Pediatric wide-field fundus photograph · 1240x1240px
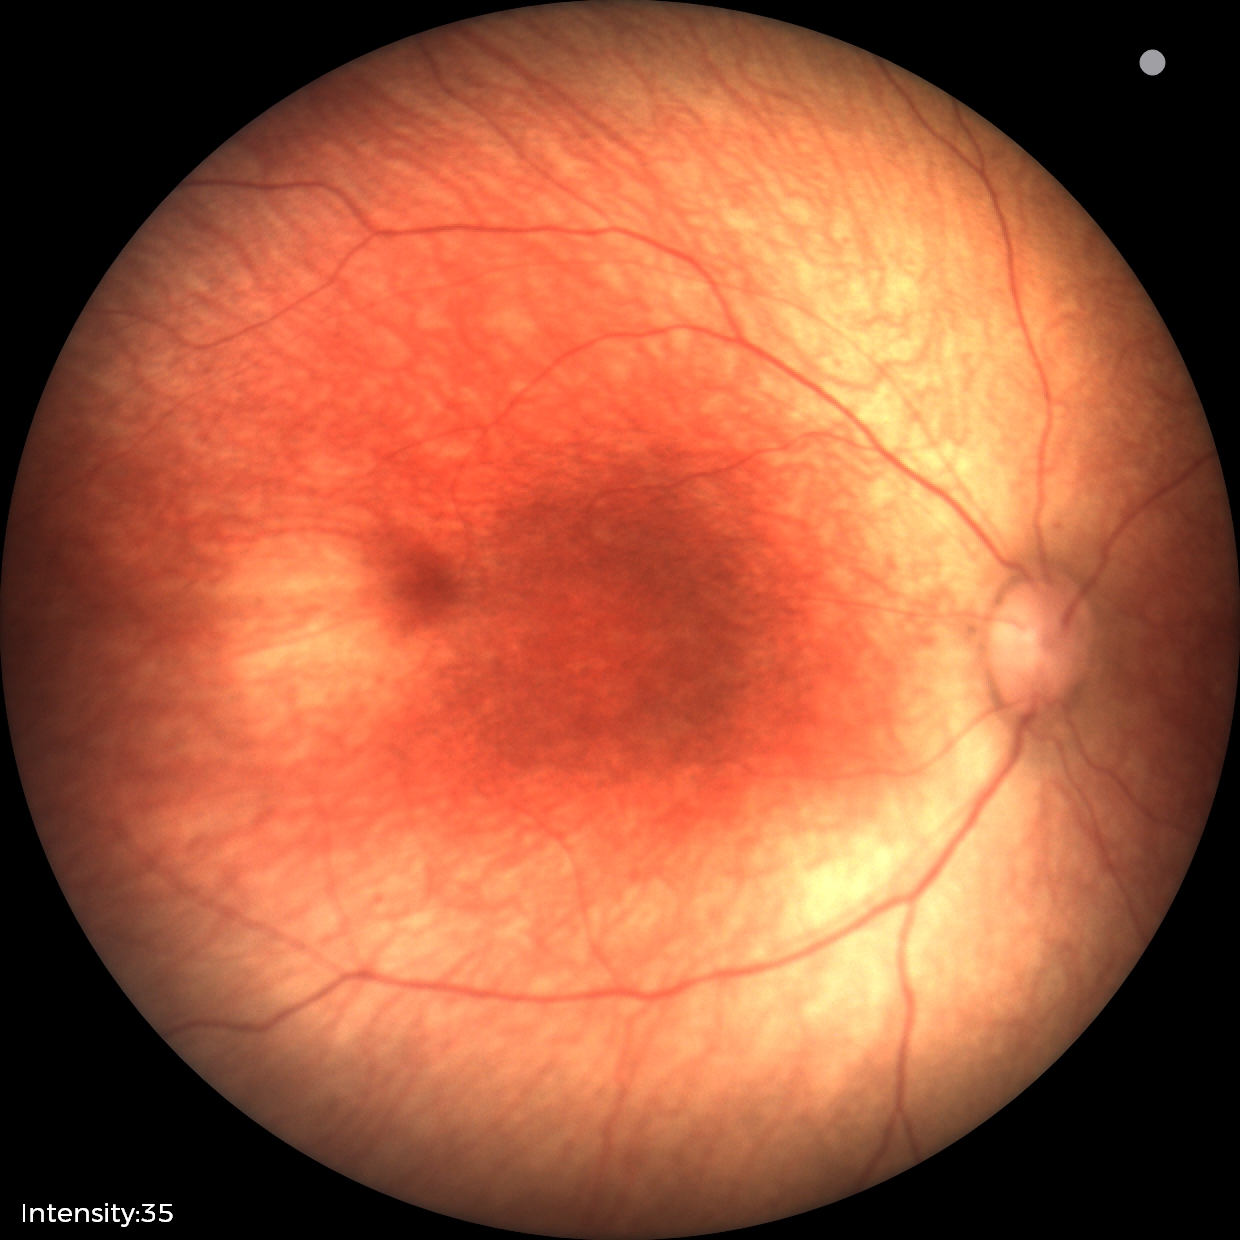
Normal screening examination.